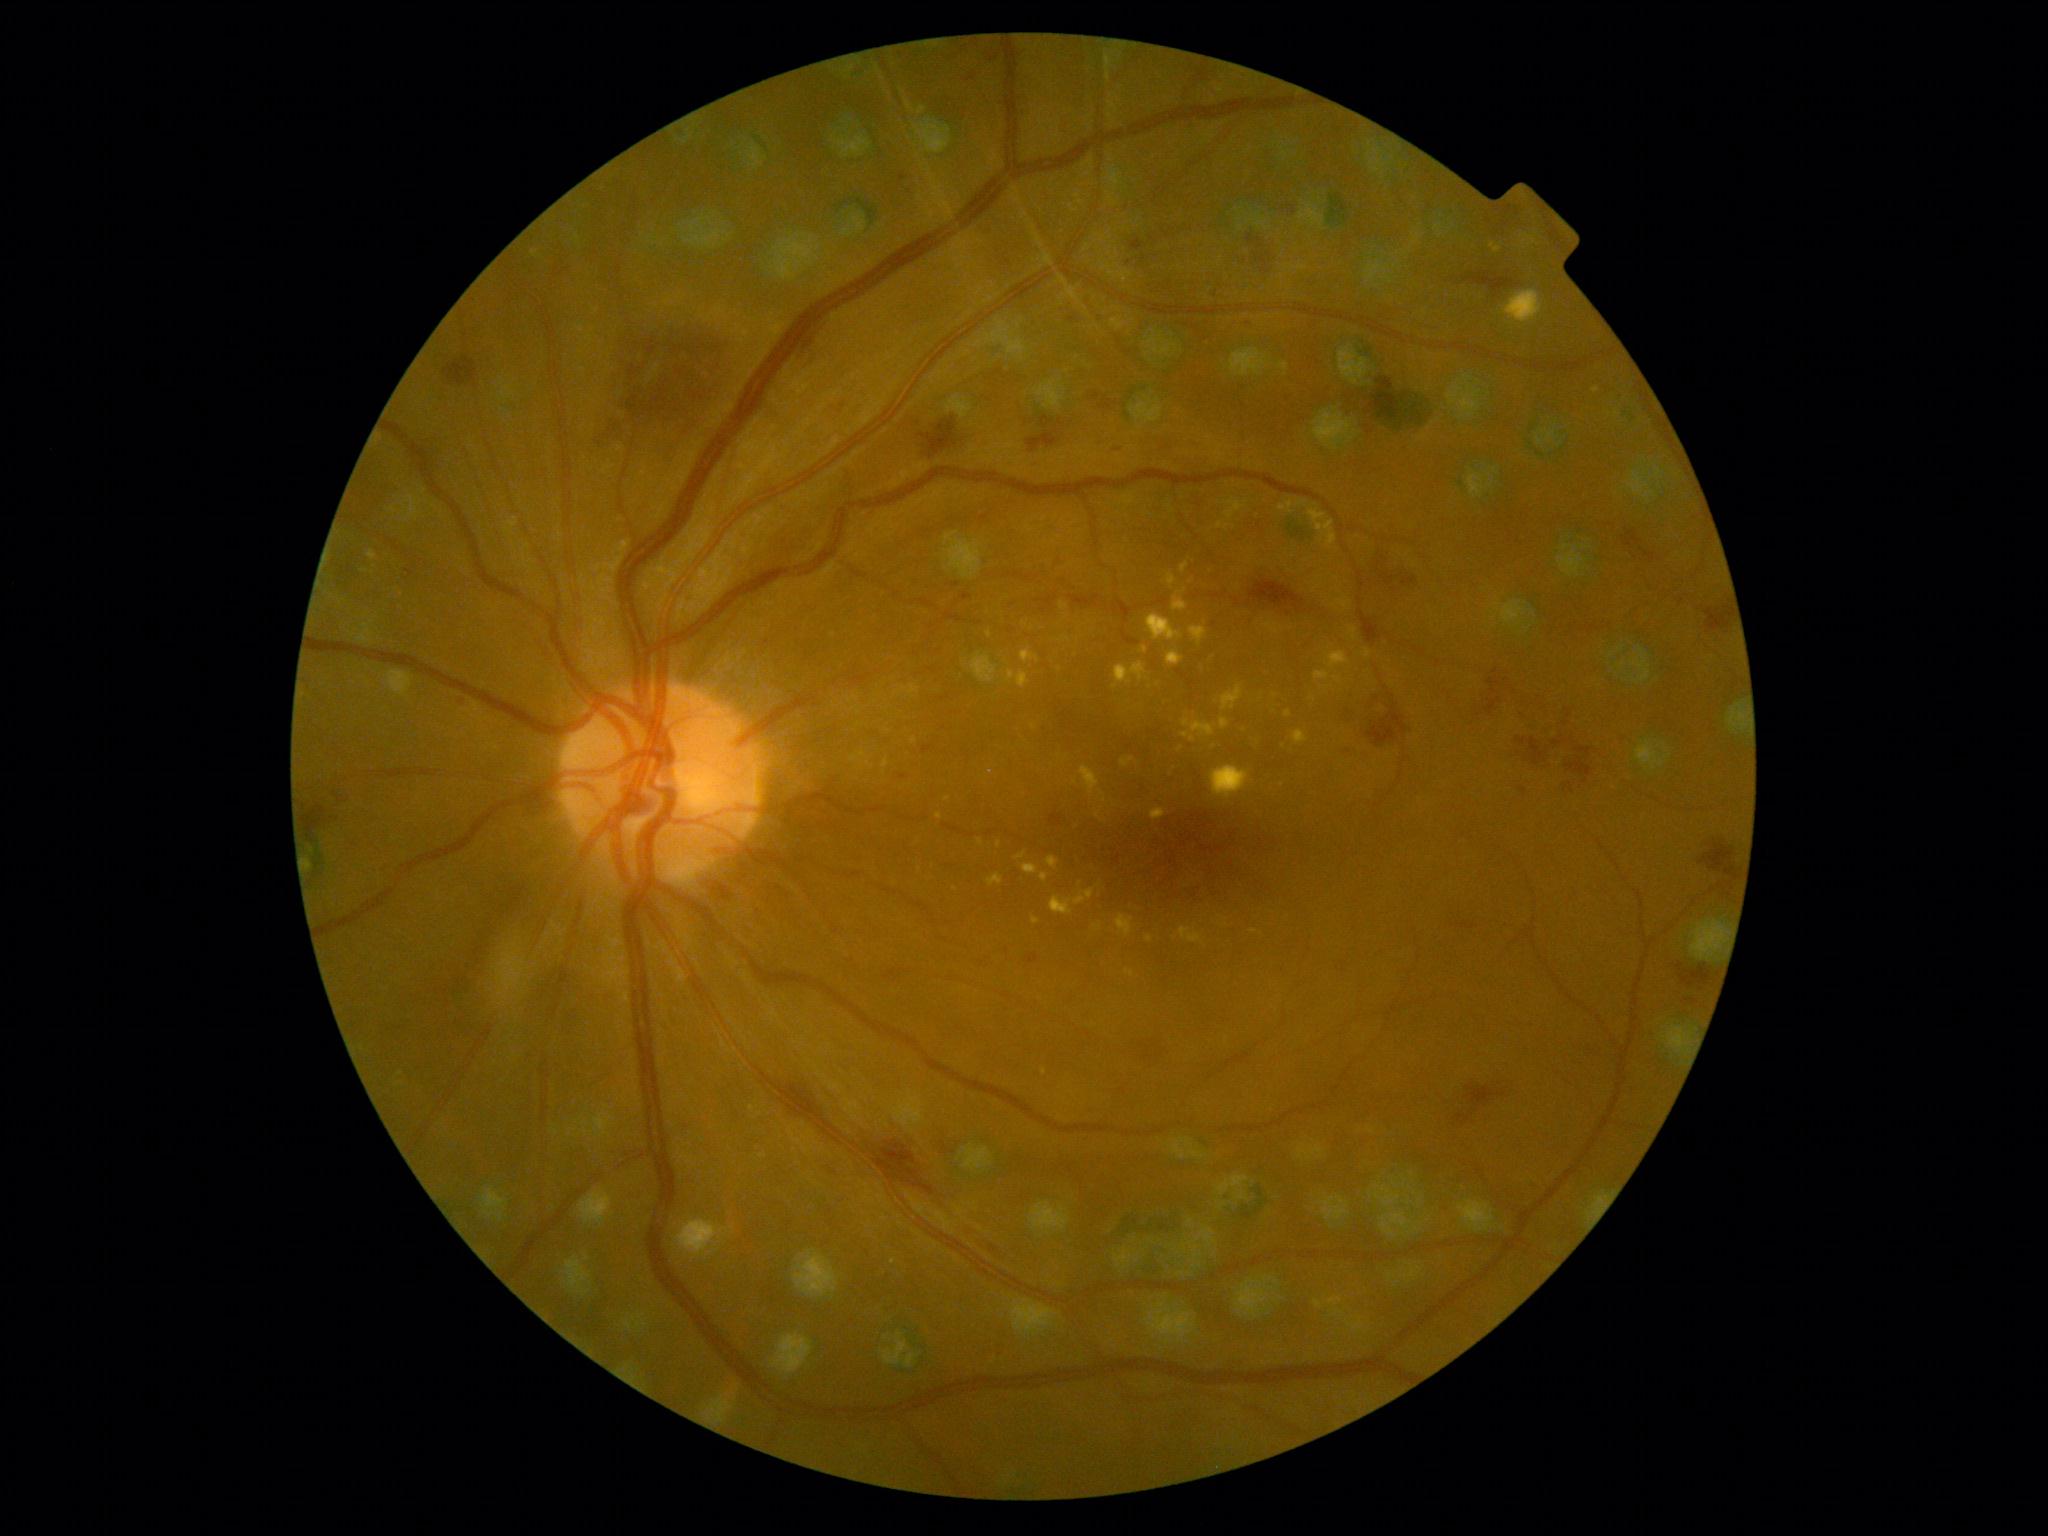
<lesions partial="true">
  <dr_grade>2</dr_grade>
  <he partial="true">left=1403, top=577, right=1418, bottom=587, left=920, top=417, right=957, bottom=460, left=1092, top=392, right=1100, bottom=401, left=1552, top=704, right=1572, bottom=745, left=1249, top=579, right=1304, bottom=613, left=1131, top=239, right=1145, bottom=252, left=1027, top=431, right=1059, bottom=453, left=1042, top=417, right=1052, bottom=430, left=1247, top=231, right=1275, bottom=272, left=407, top=567, right=416, bottom=577, left=874, top=1140, right=936, bottom=1196, left=1380, top=574, right=1394, bottom=586, left=1529, top=737, right=1545, bottom=766</he>
  <he_small_approx>{"x": 1524, "y": 791}, {"x": 956, "y": 585}, {"x": 1007, "y": 951}</he_small_approx>
  <ex partial="true">left=1040, top=873, right=1049, bottom=883, left=1080, top=766, right=1100, bottom=796, left=1023, top=863, right=1039, bottom=875, left=1490, top=243, right=1502, bottom=254, left=1211, top=766, right=1249, bottom=799, left=1146, top=614, right=1184, bottom=642, left=1325, top=651, right=1351, bottom=670, left=1020, top=649, right=1040, bottom=663, left=1168, top=574, right=1178, bottom=589, left=1016, top=853, right=1026, bottom=861, left=1116, top=915, right=1135, bottom=938, left=1146, top=935, right=1153, bottom=944, left=1173, top=596, right=1188, bottom=611</ex>
  <ex_small_approx>{"x": 999, "y": 845}, {"x": 1185, "y": 735}, {"x": 980, "y": 842}, {"x": 1288, "y": 713}, {"x": 365, "y": 571}</ex_small_approx>
</lesions>